50° field of view, pupil-dilated: 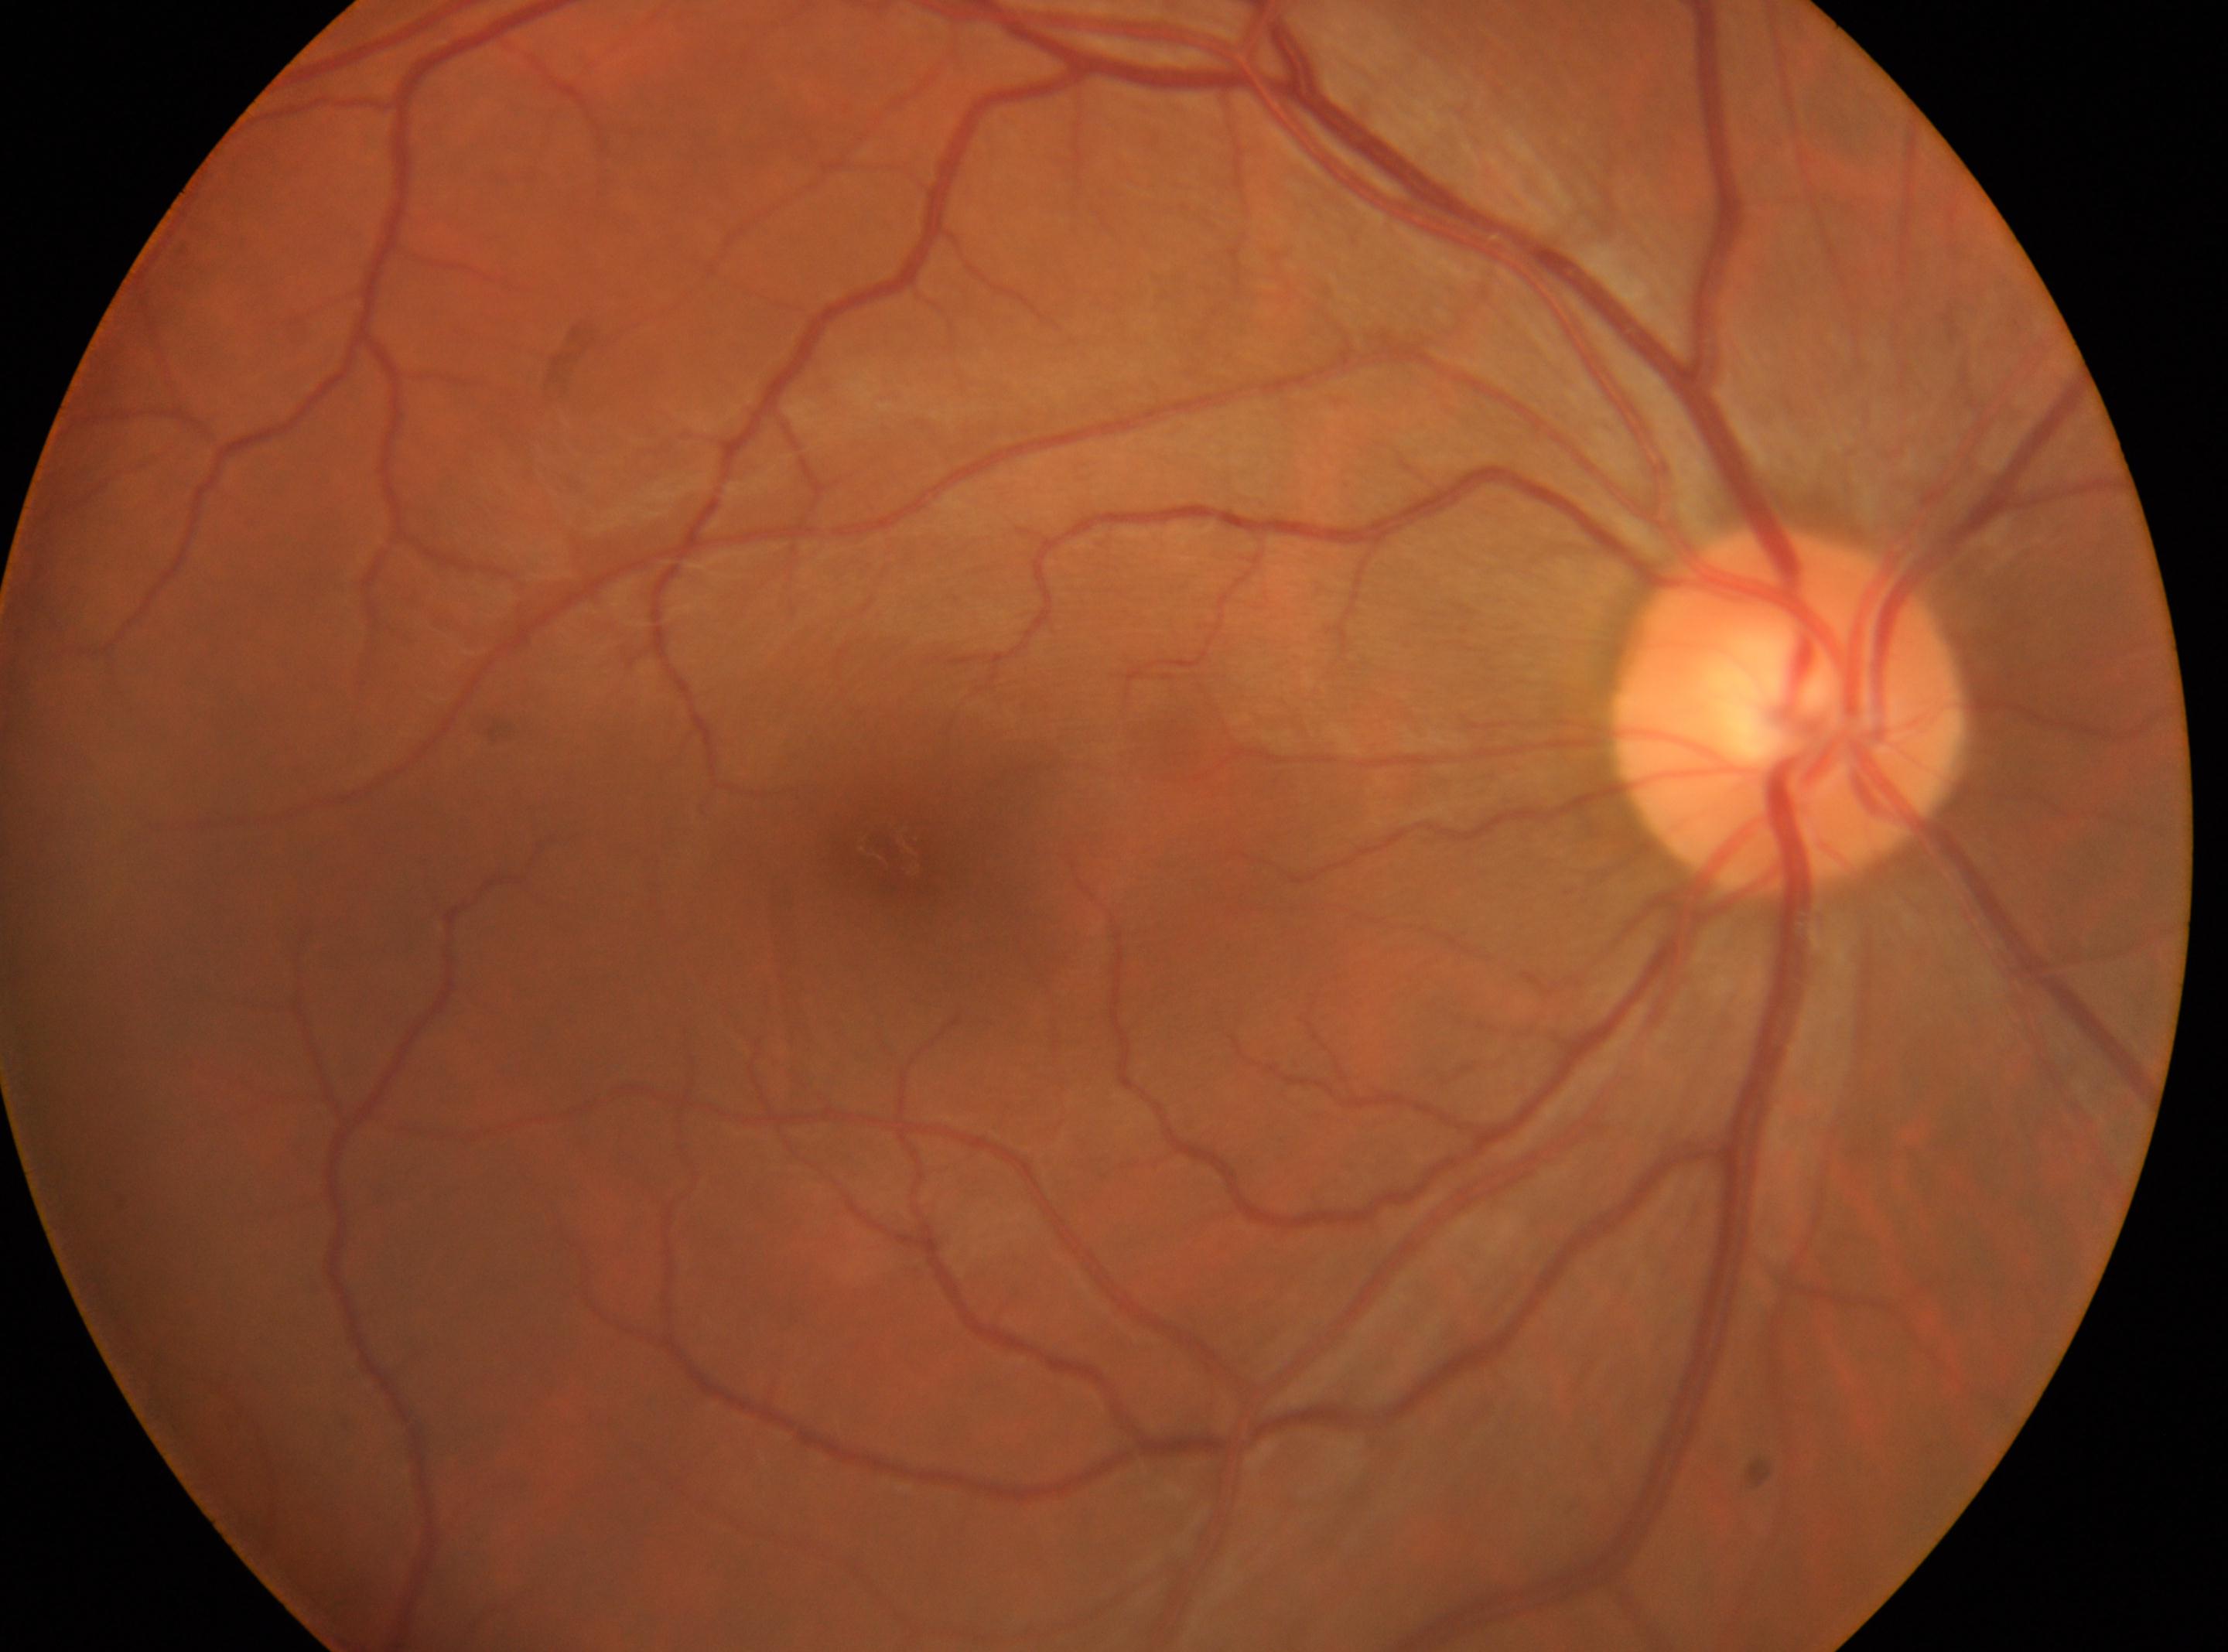

eye: OD
macular center: 891px, 860px
DR grade: 0
optic disc center: 1789px, 710px